1440x1080px; infant wide-field fundus photograph
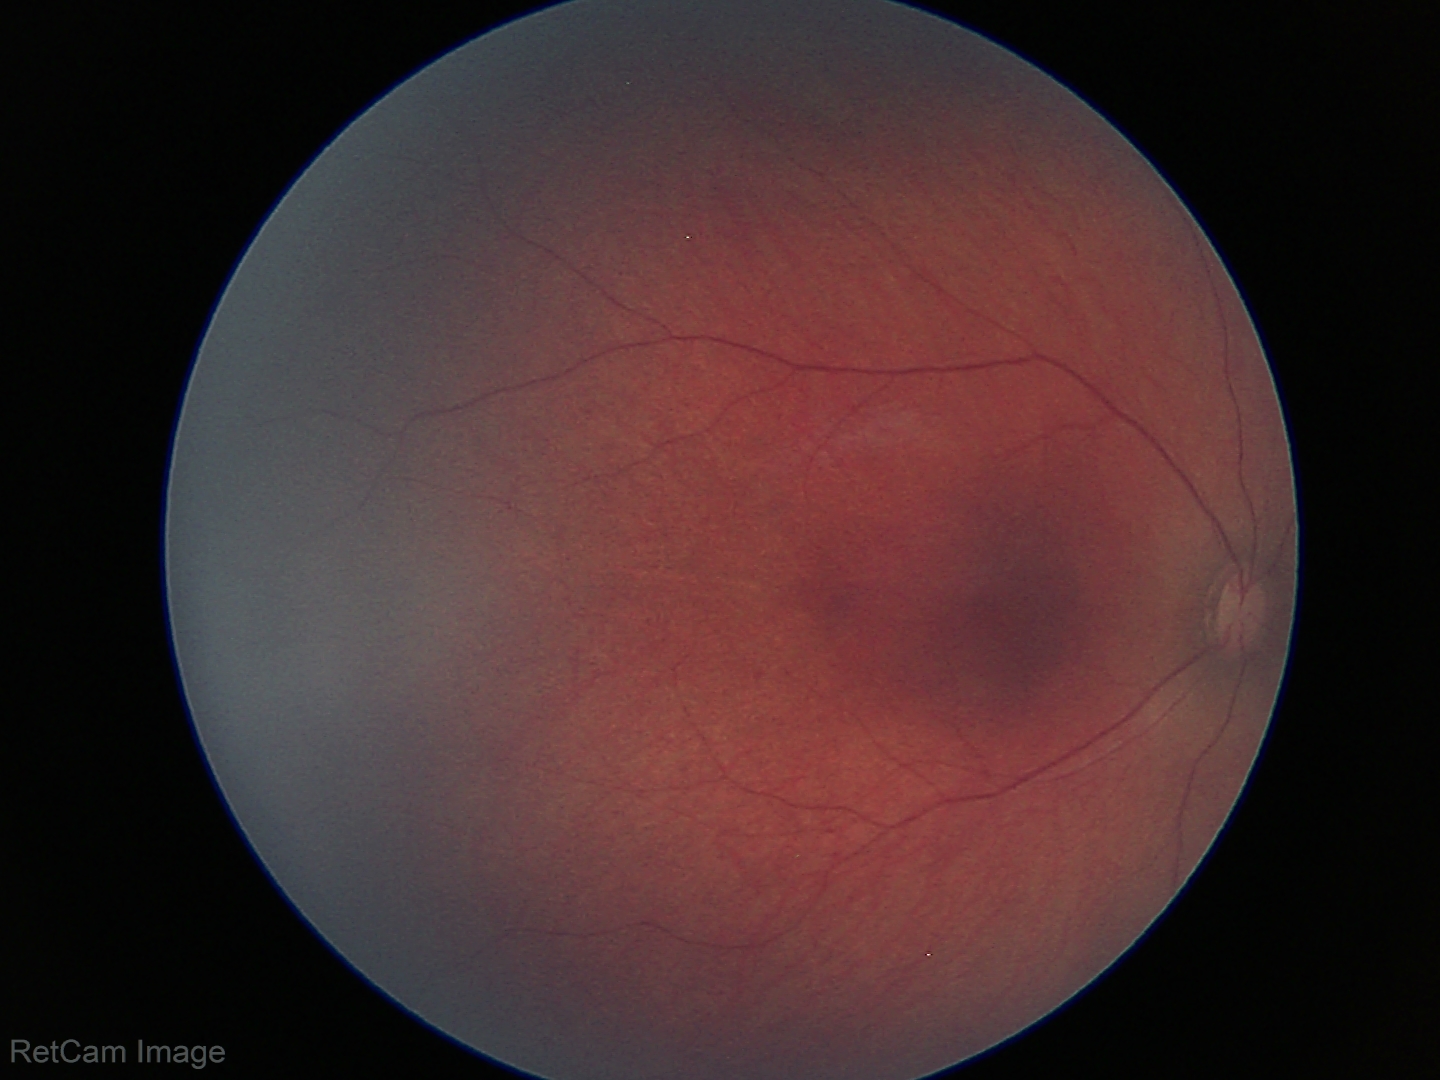 Impression: normal retinal appearance.